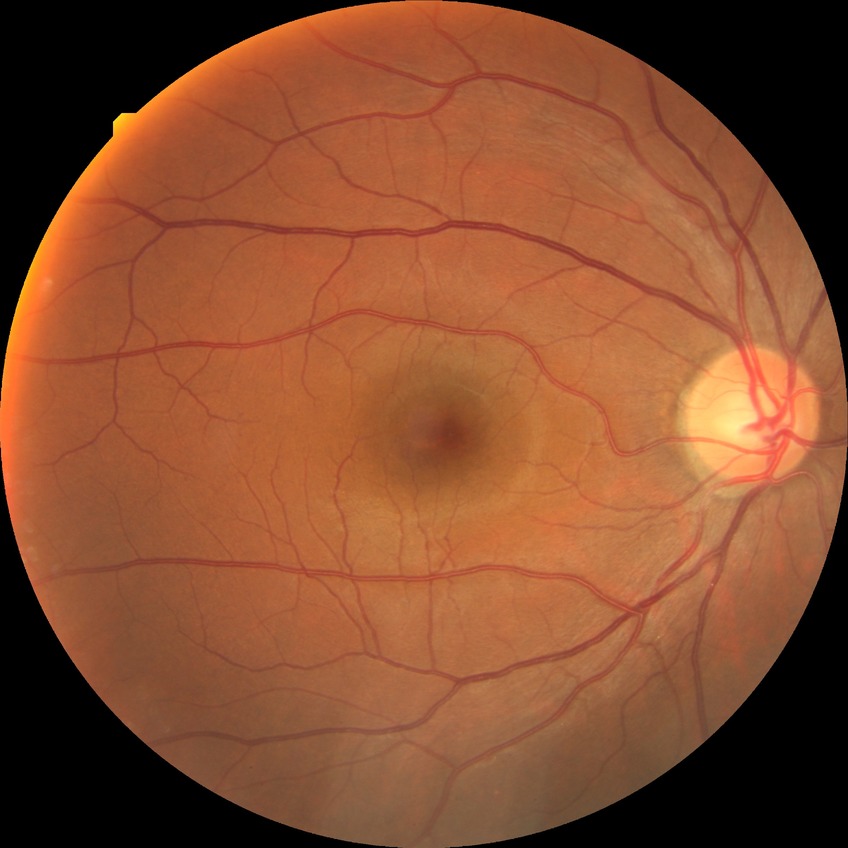
Davis grading is no diabetic retinopathy.